Wide-field contact fundus photograph of an infant · acquired on the Phoenix ICON — 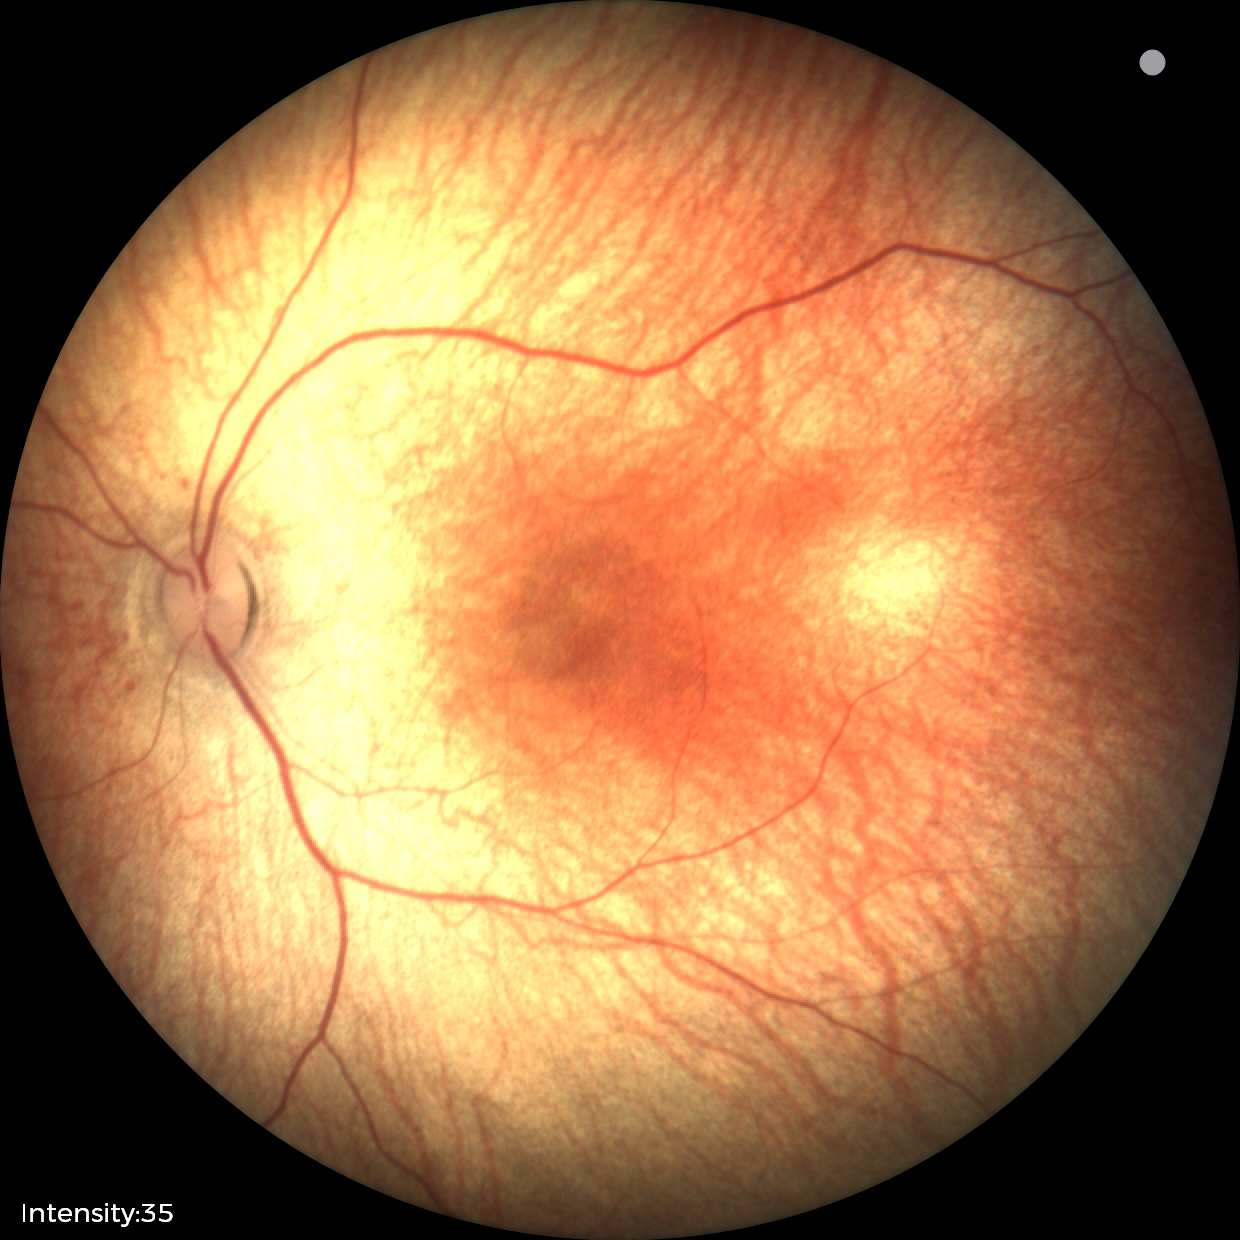 Diagnosis: physiological appearance.